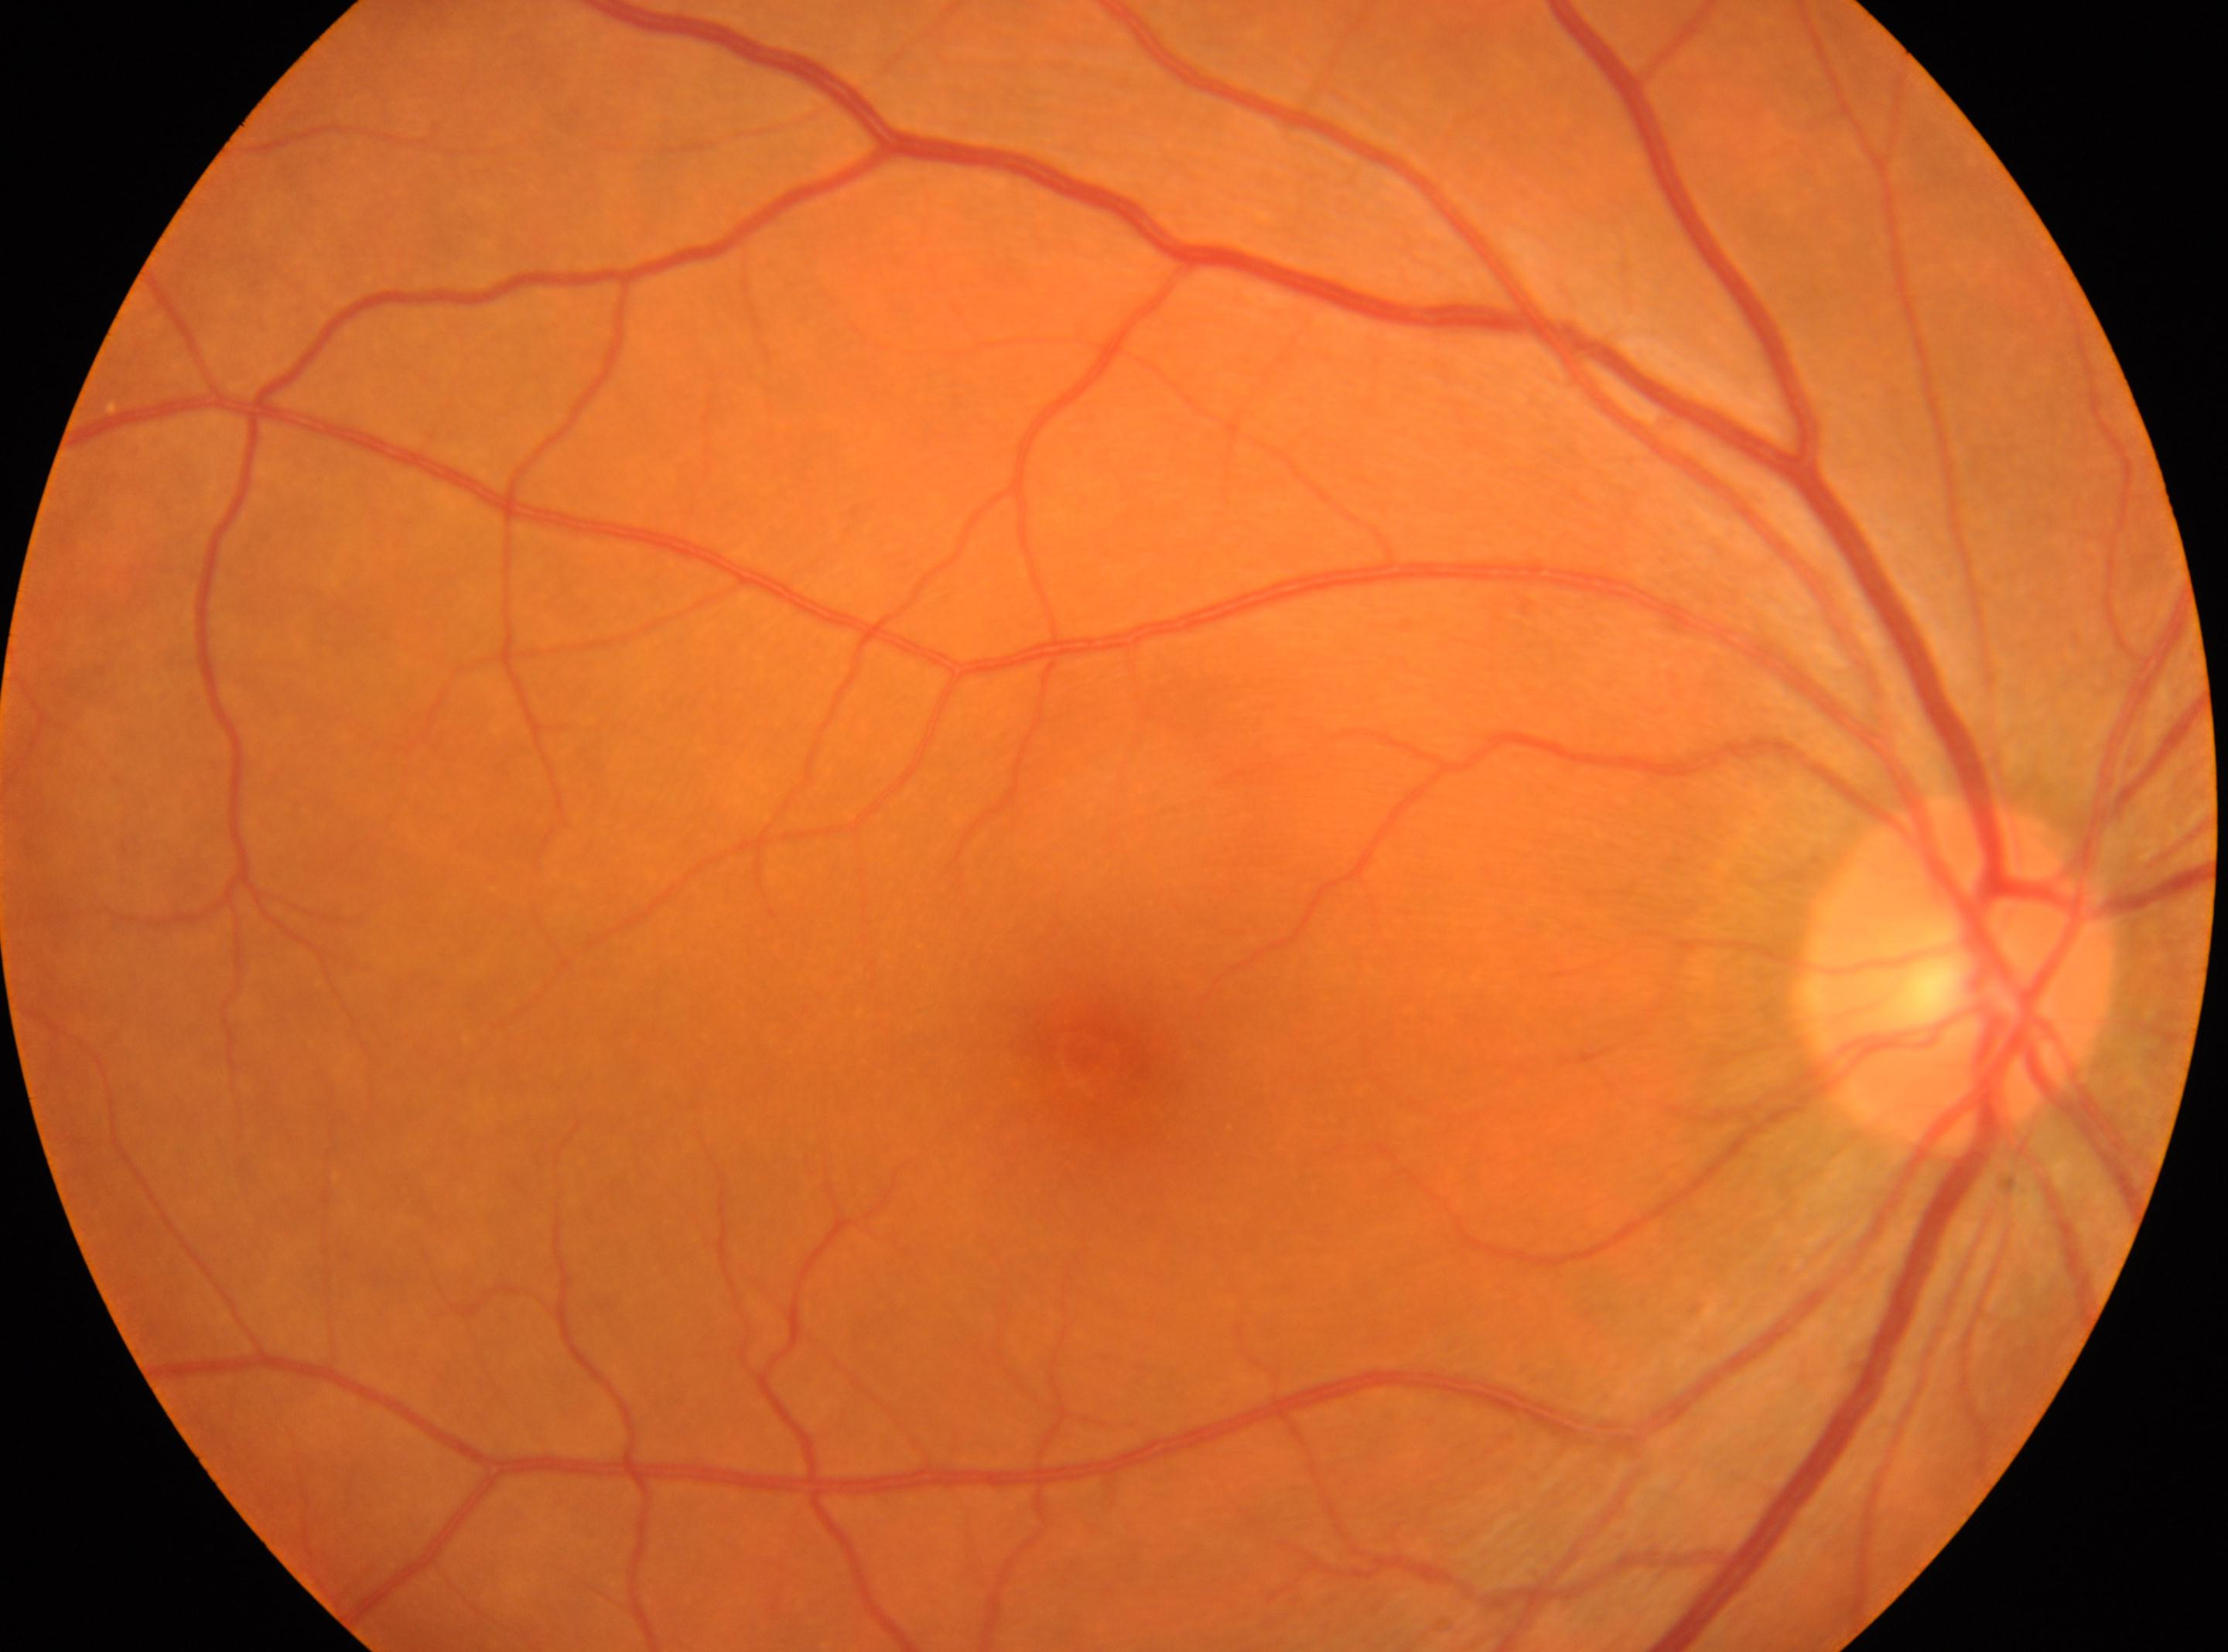 Q: What is the laterality?
A: the right eye
Q: Locate the optic disc.
A: (x=1954, y=970)
Q: Diabetic retinopathy severity?
A: 0/4
Q: Where is the fovea?
A: (x=1086, y=1058)